No pharmacologic dilation.
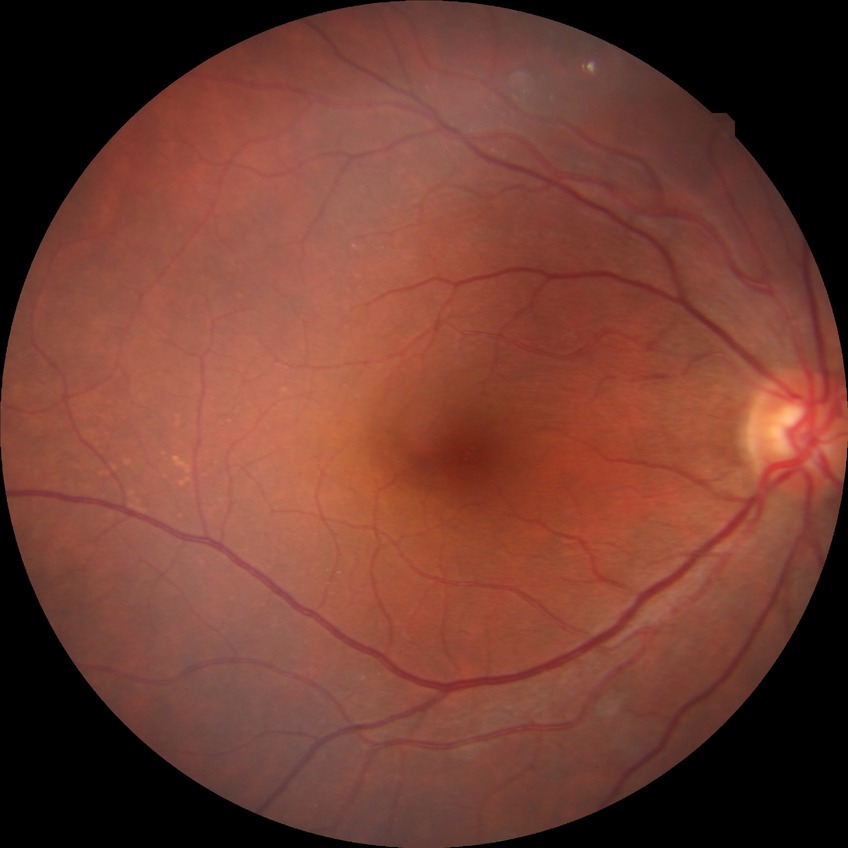
Diabetic retinopathy (DR): no diabetic retinopathy (NDR).